2212 x 1672 pixels:
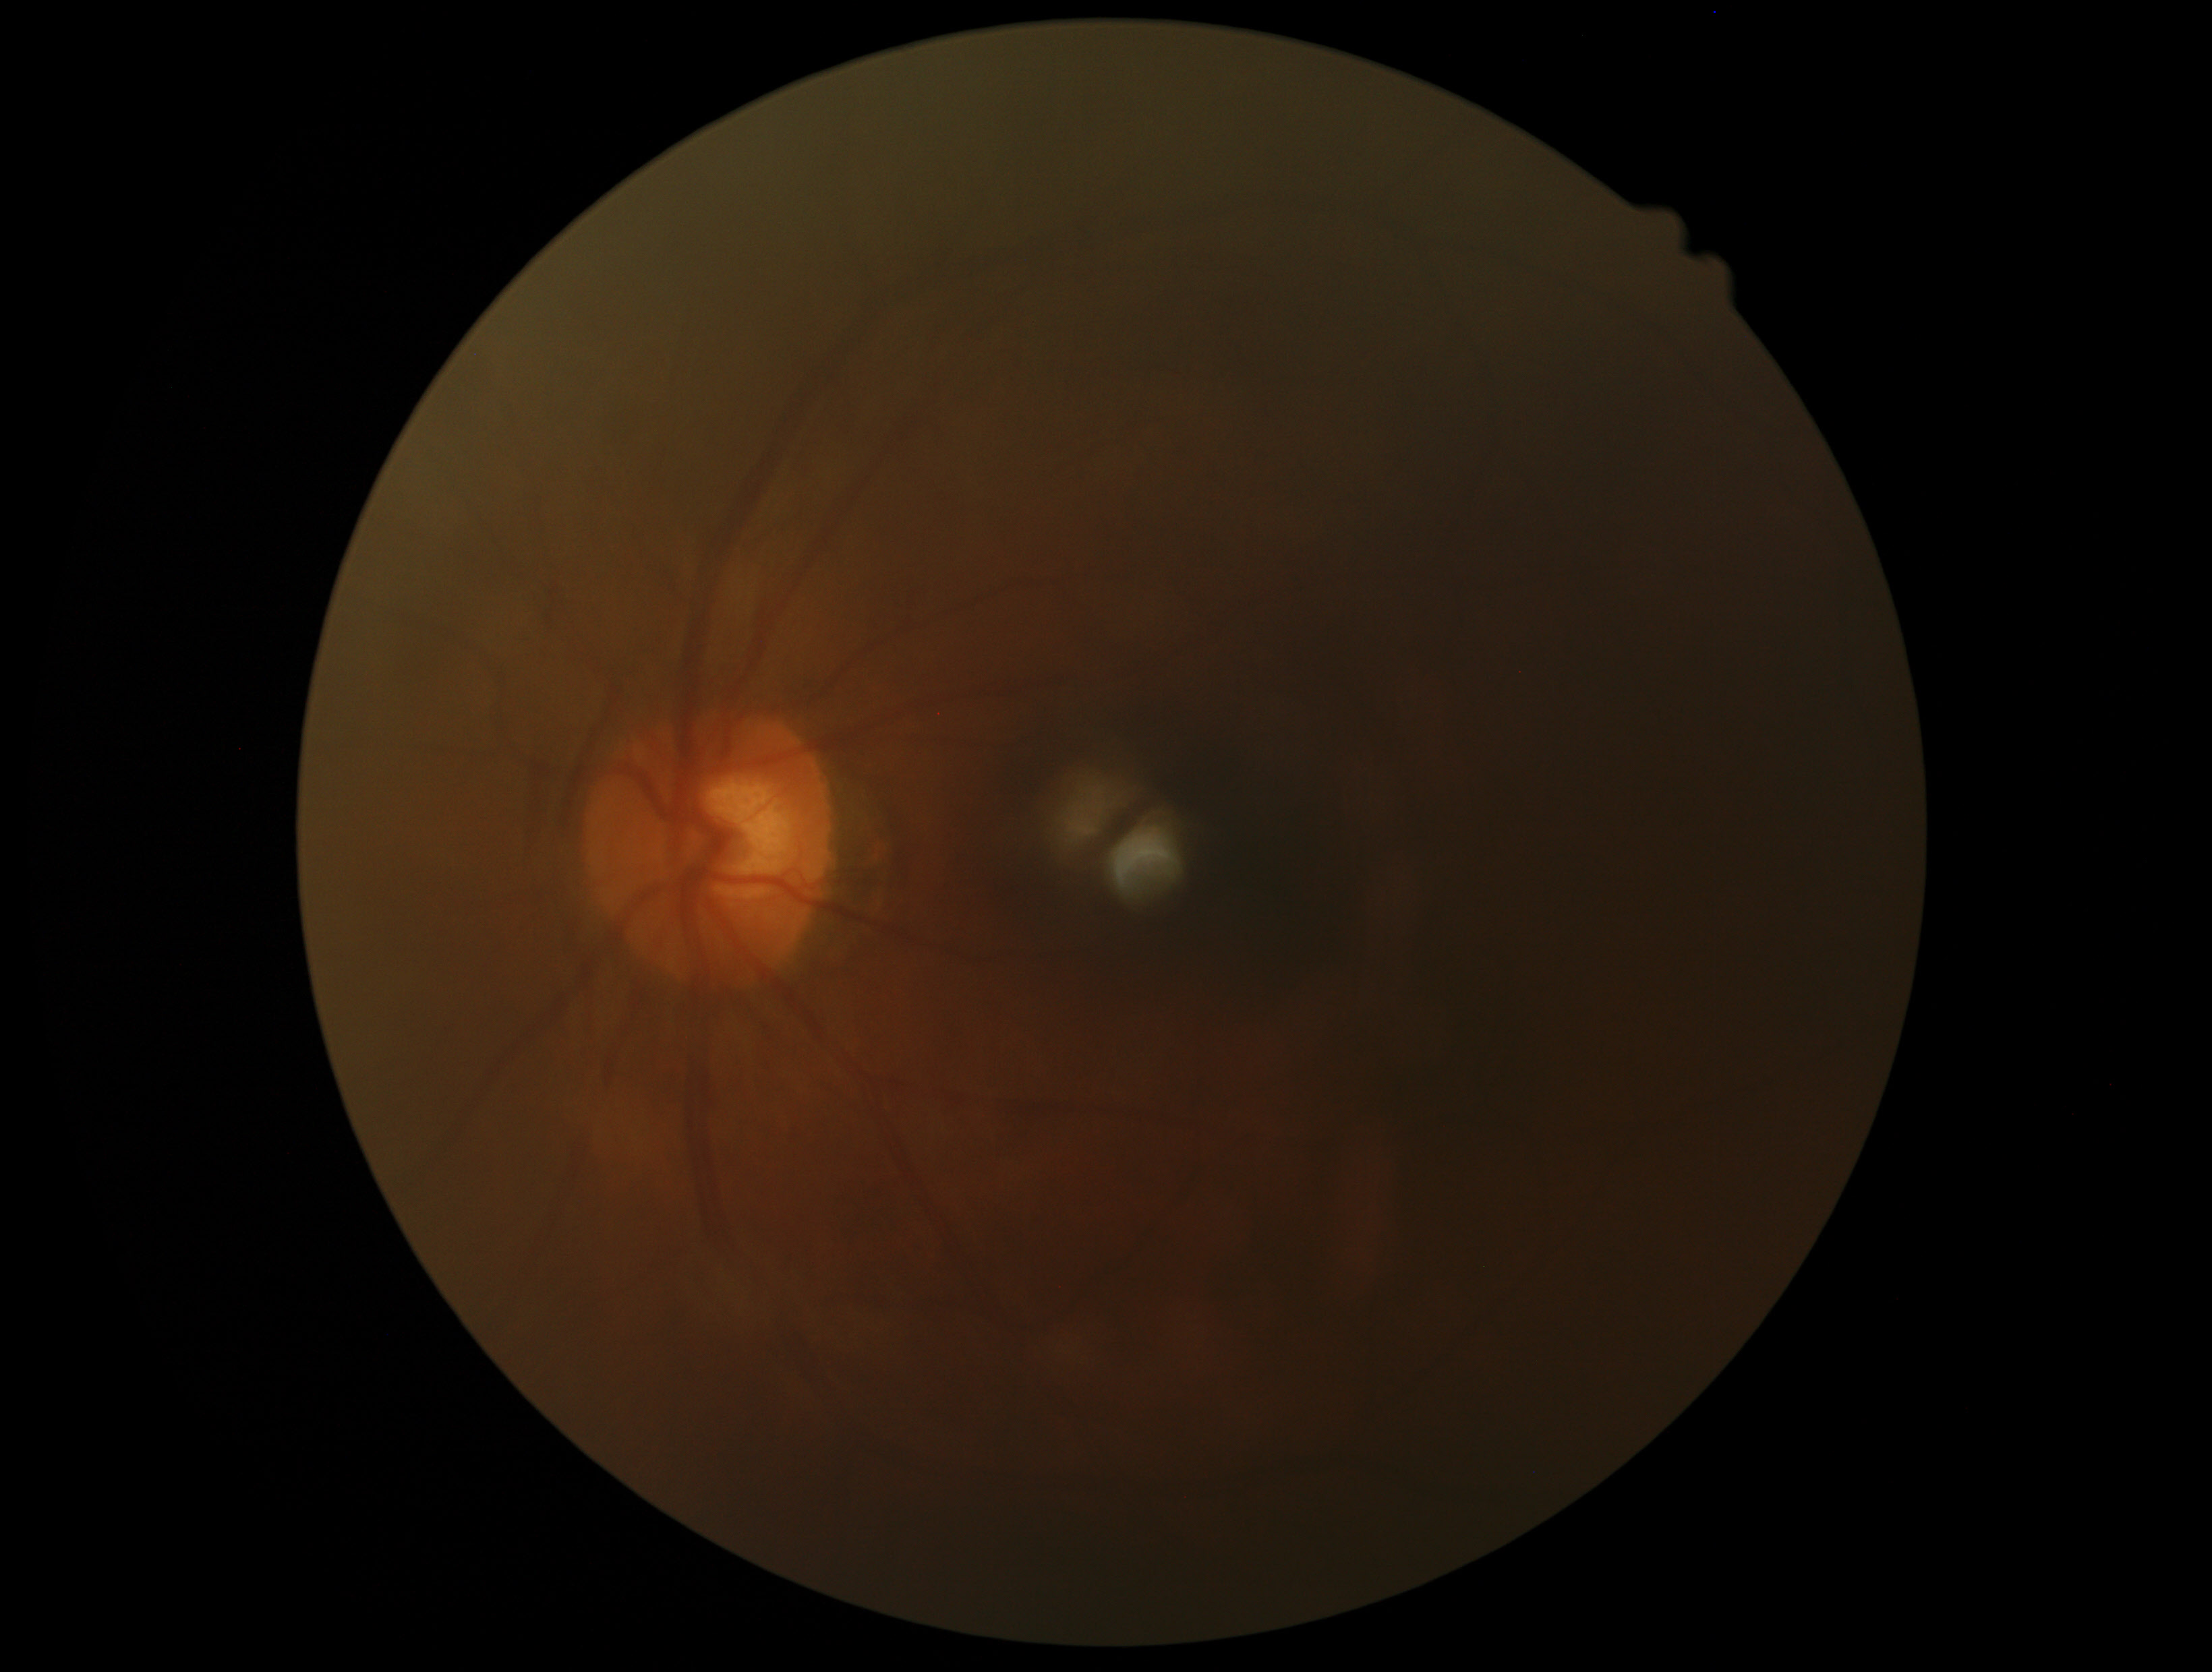

DR stage is 0. No apparent diabetic retinopathy.